CFP. 45-degree field of view. Without pupil dilation
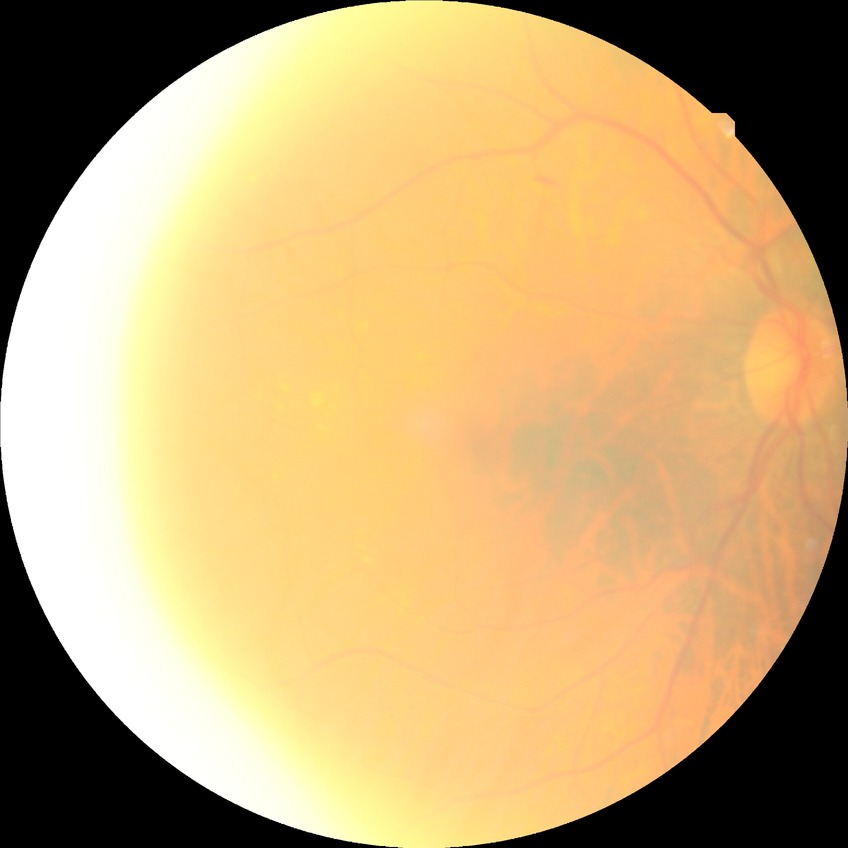 Diabetic retinopathy (DR): no diabetic retinopathy (NDR).